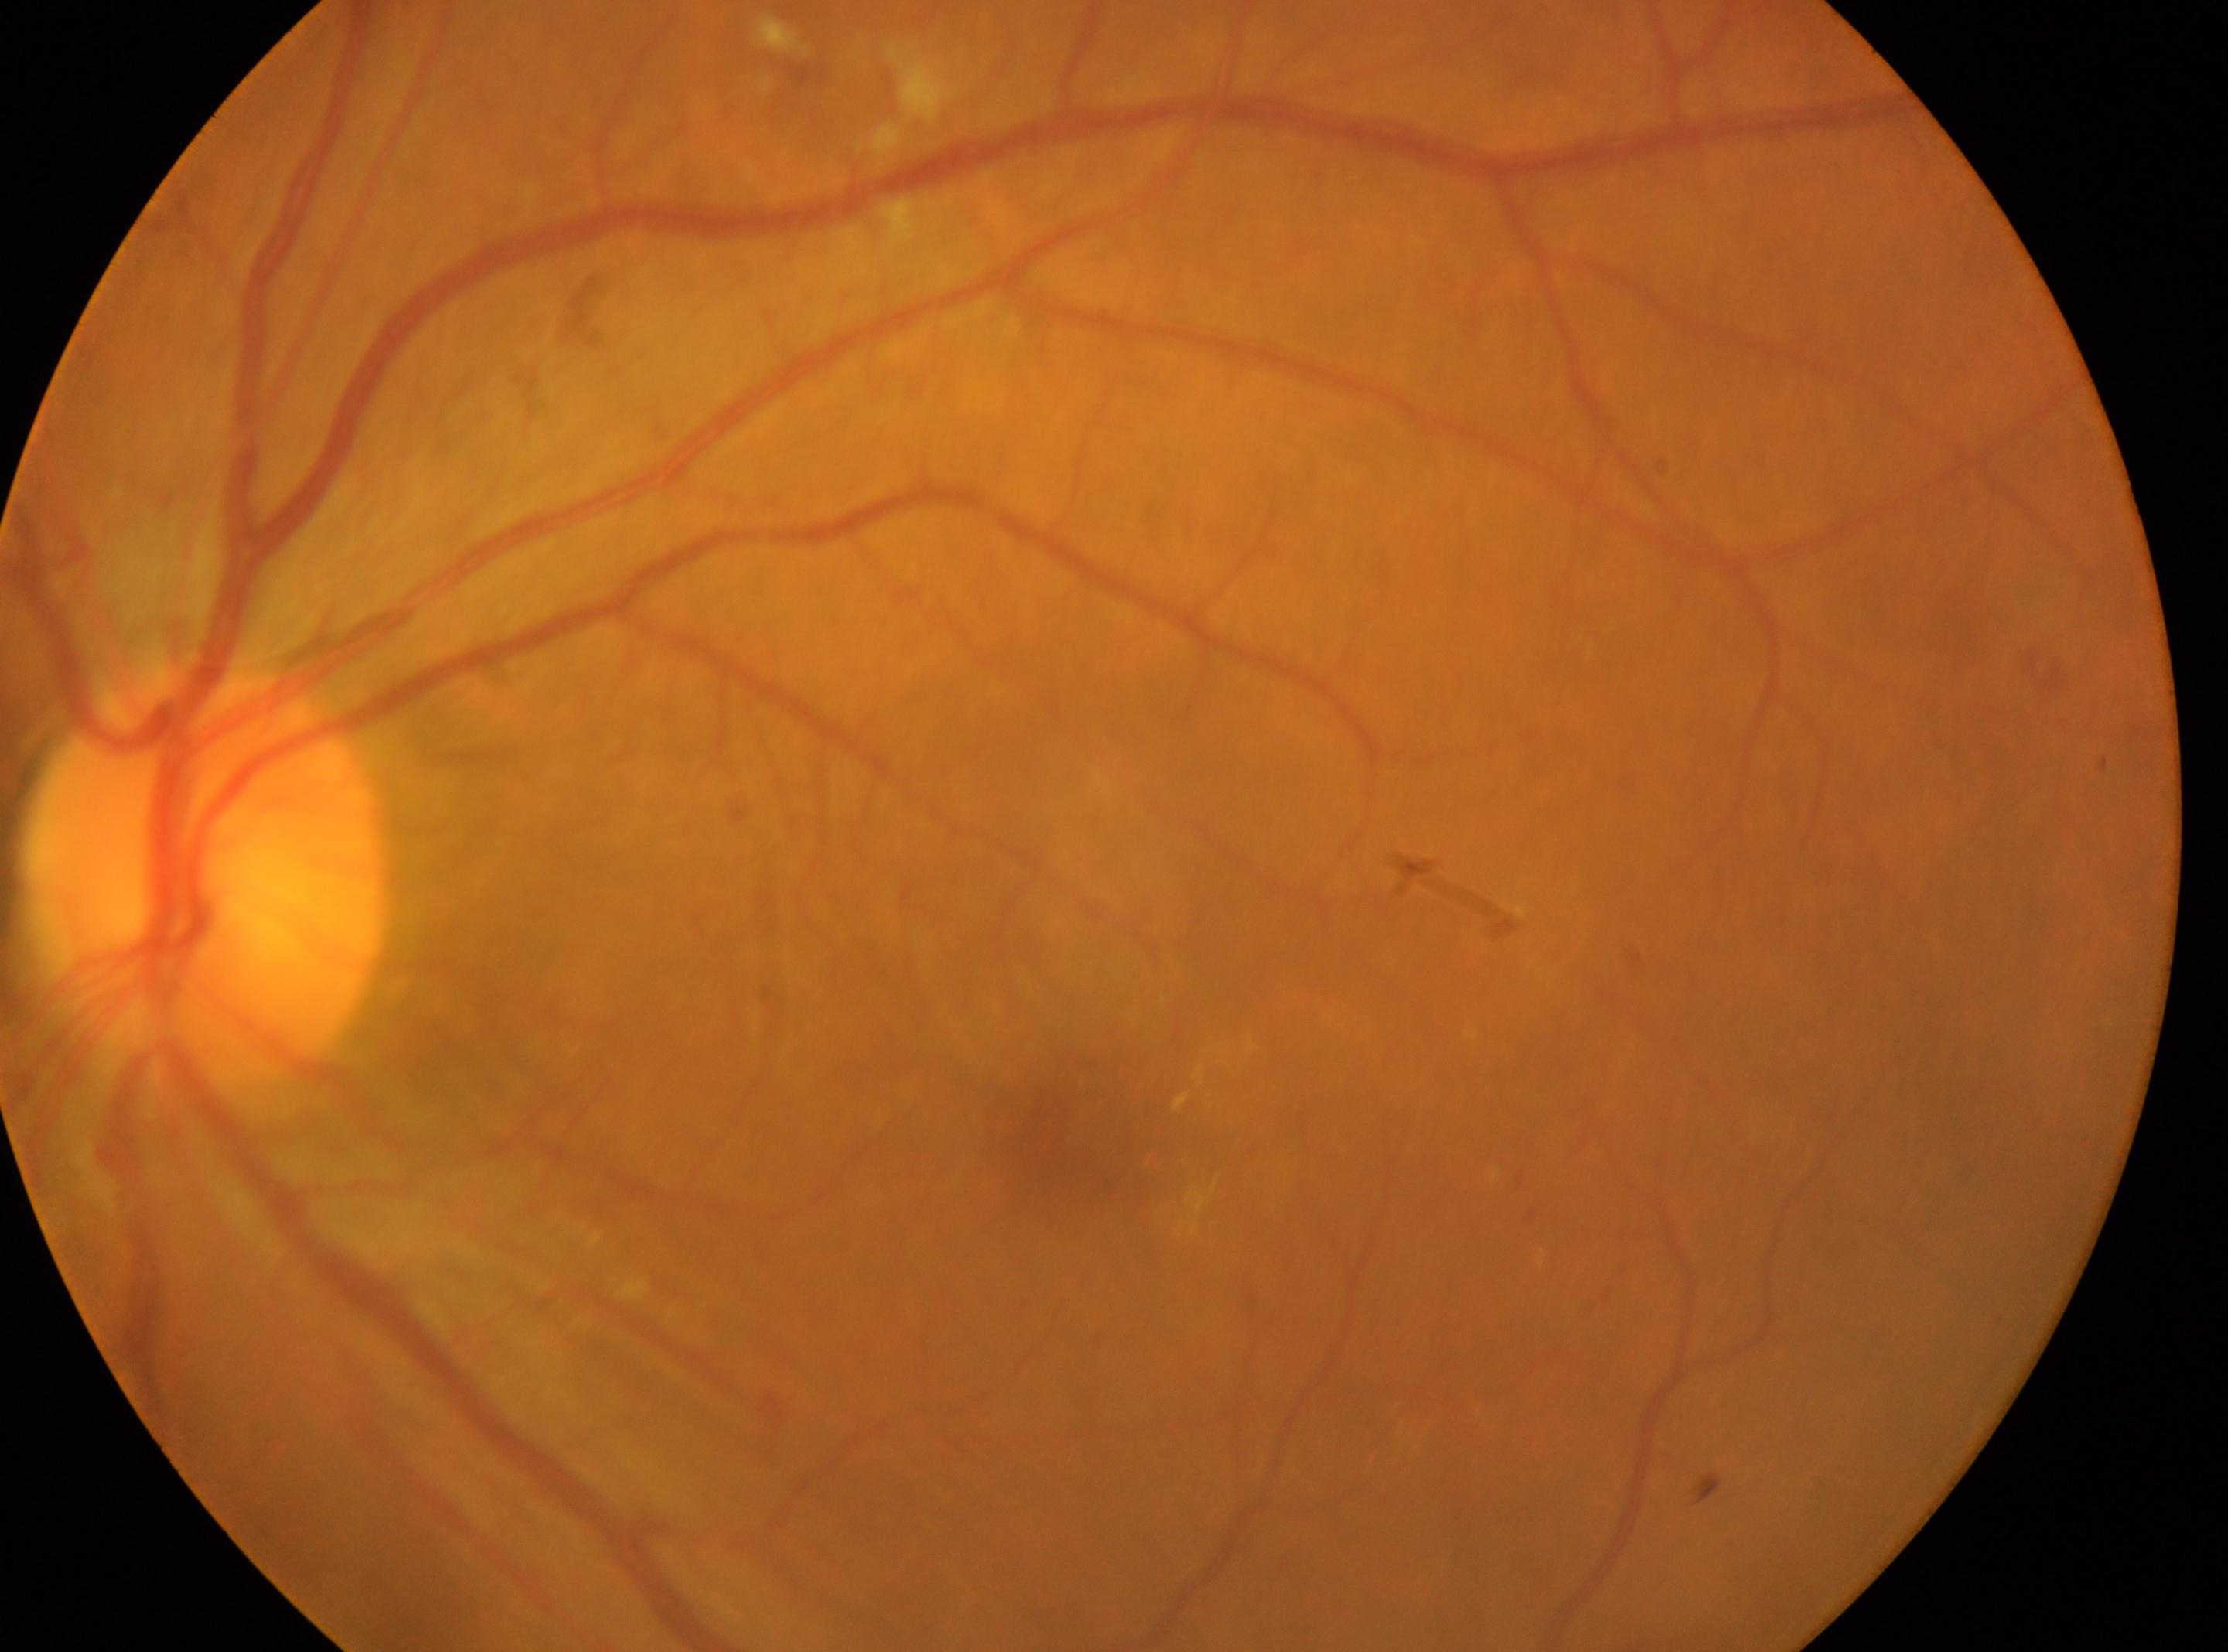

oculus sinister; macular center: (1058, 1131); DR severity: 2/4; ONH: (204, 879).